Remidio smartphone fundus camera: 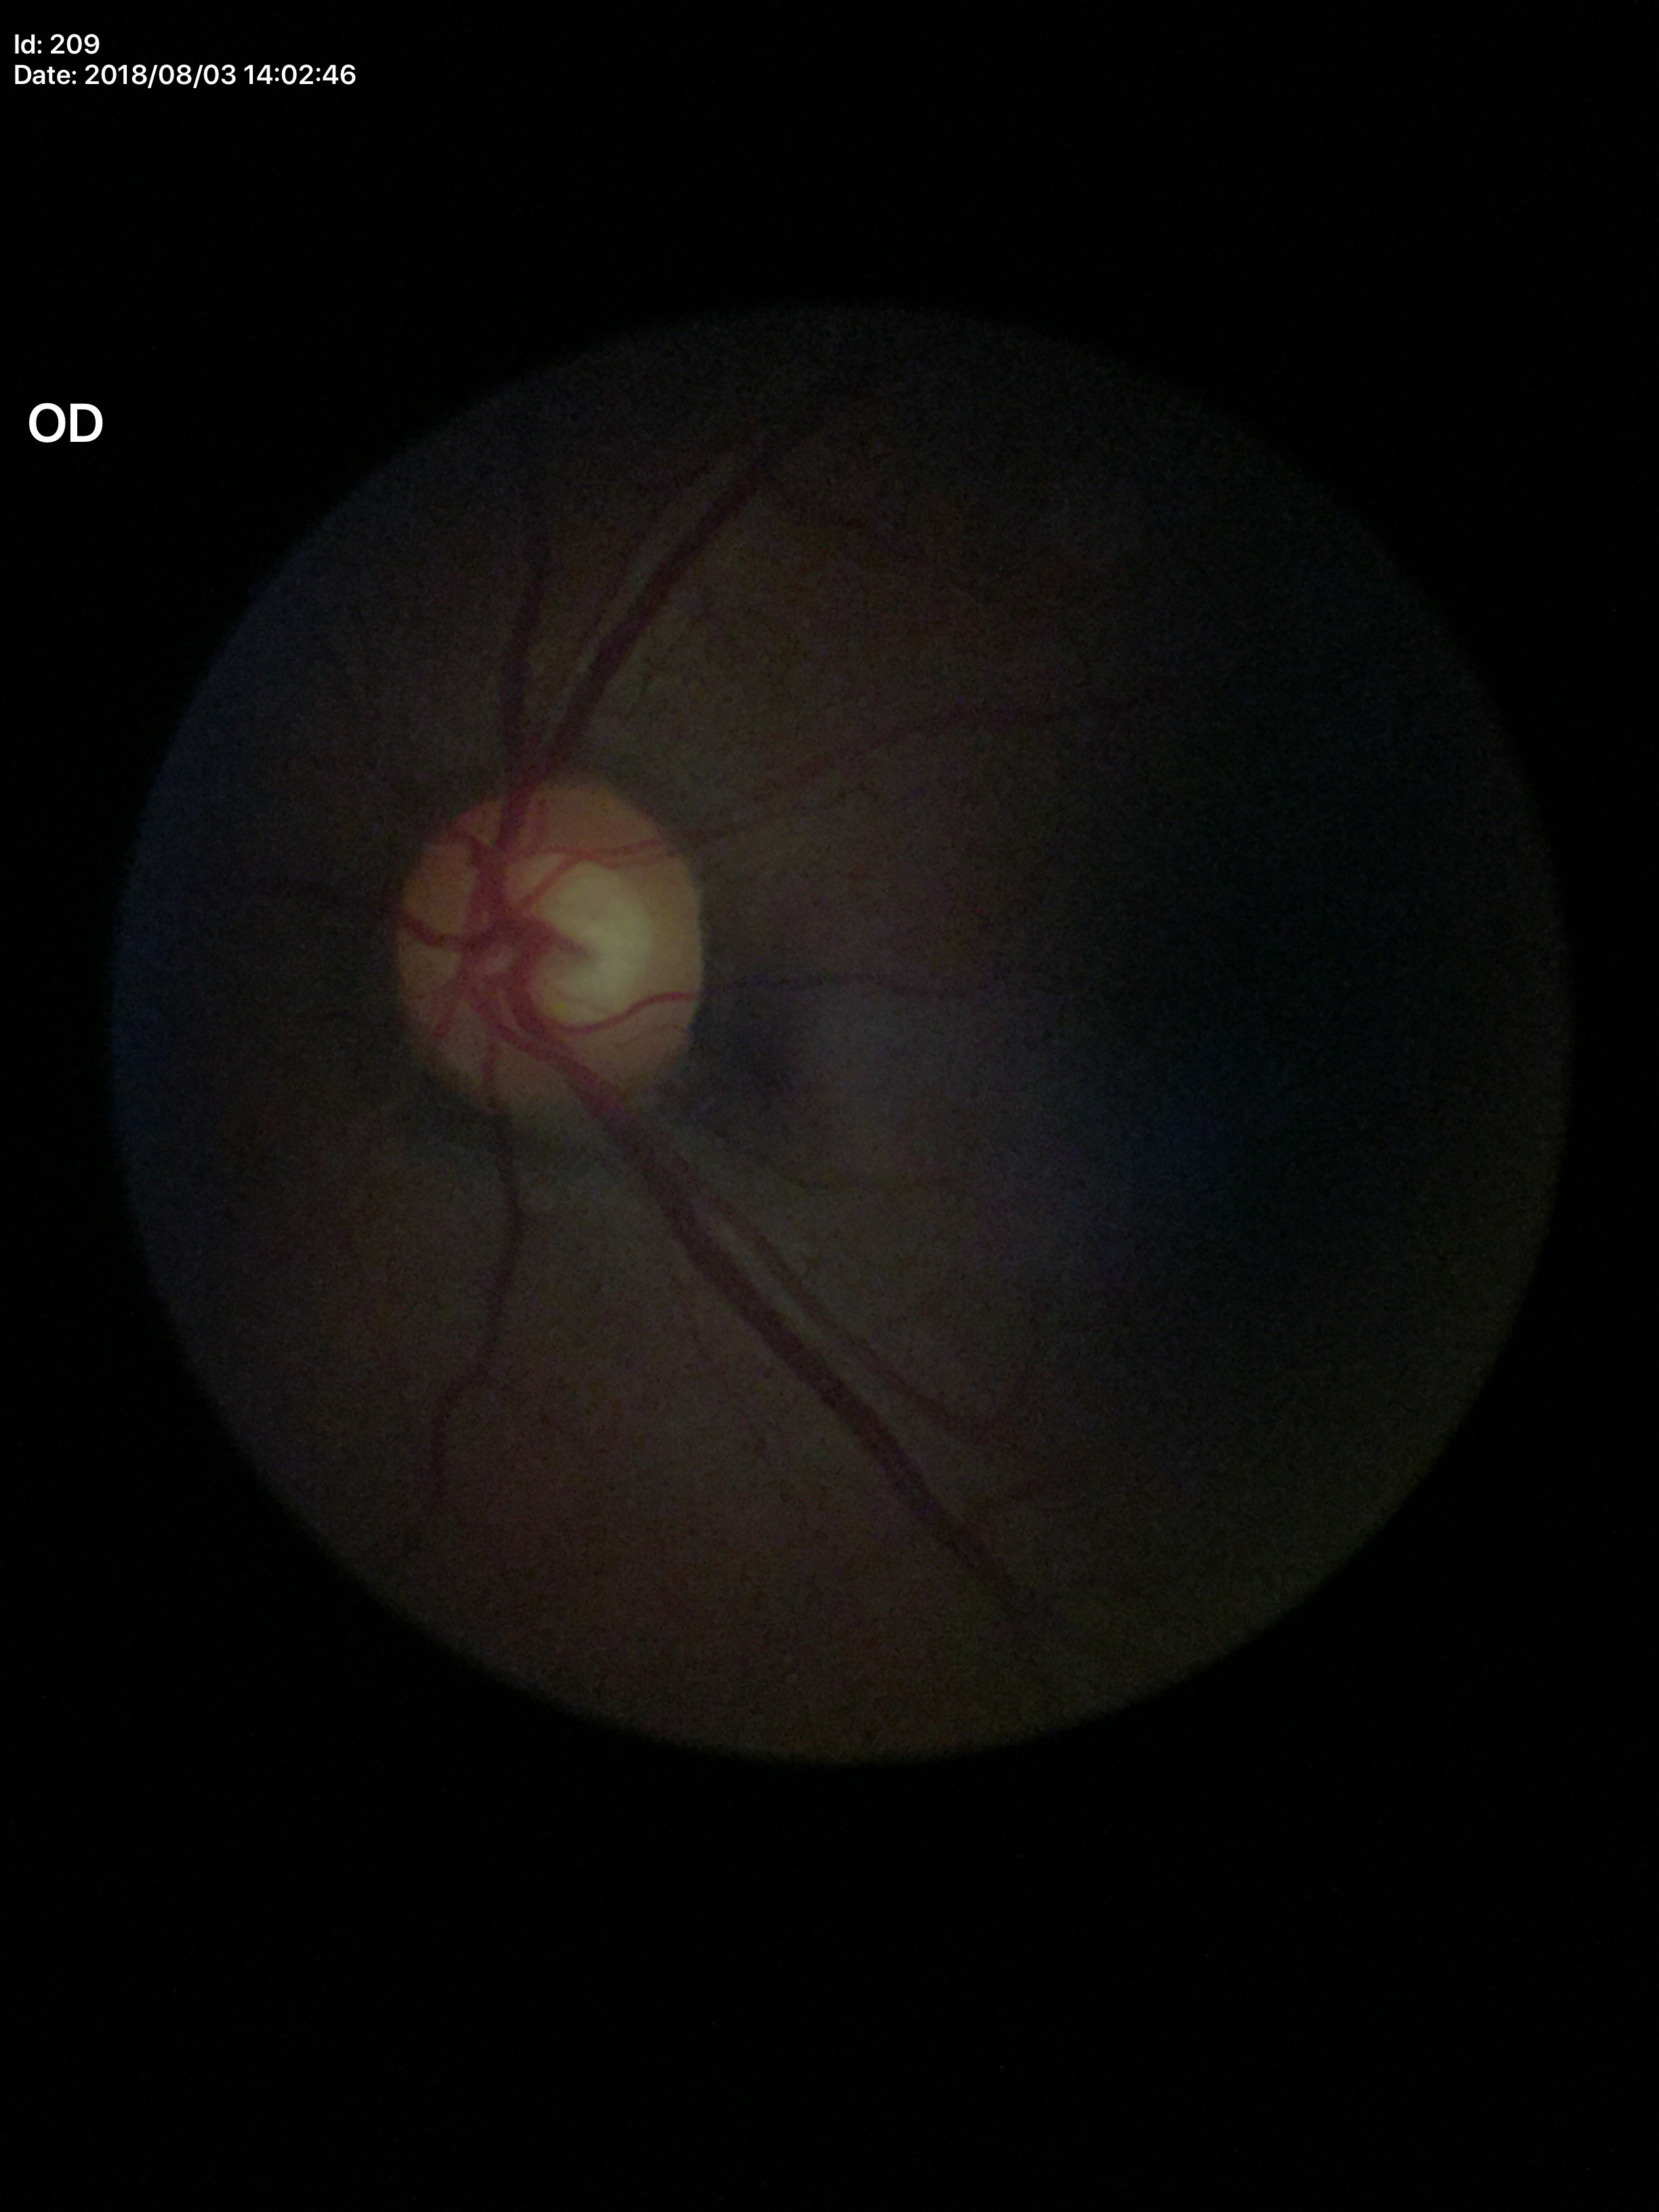
Vertical cup-disc ratio (VCDR) of 0.56.
Glaucoma assessment: no suspicious findings (2 of 5 graders flagged glaucoma suspect).